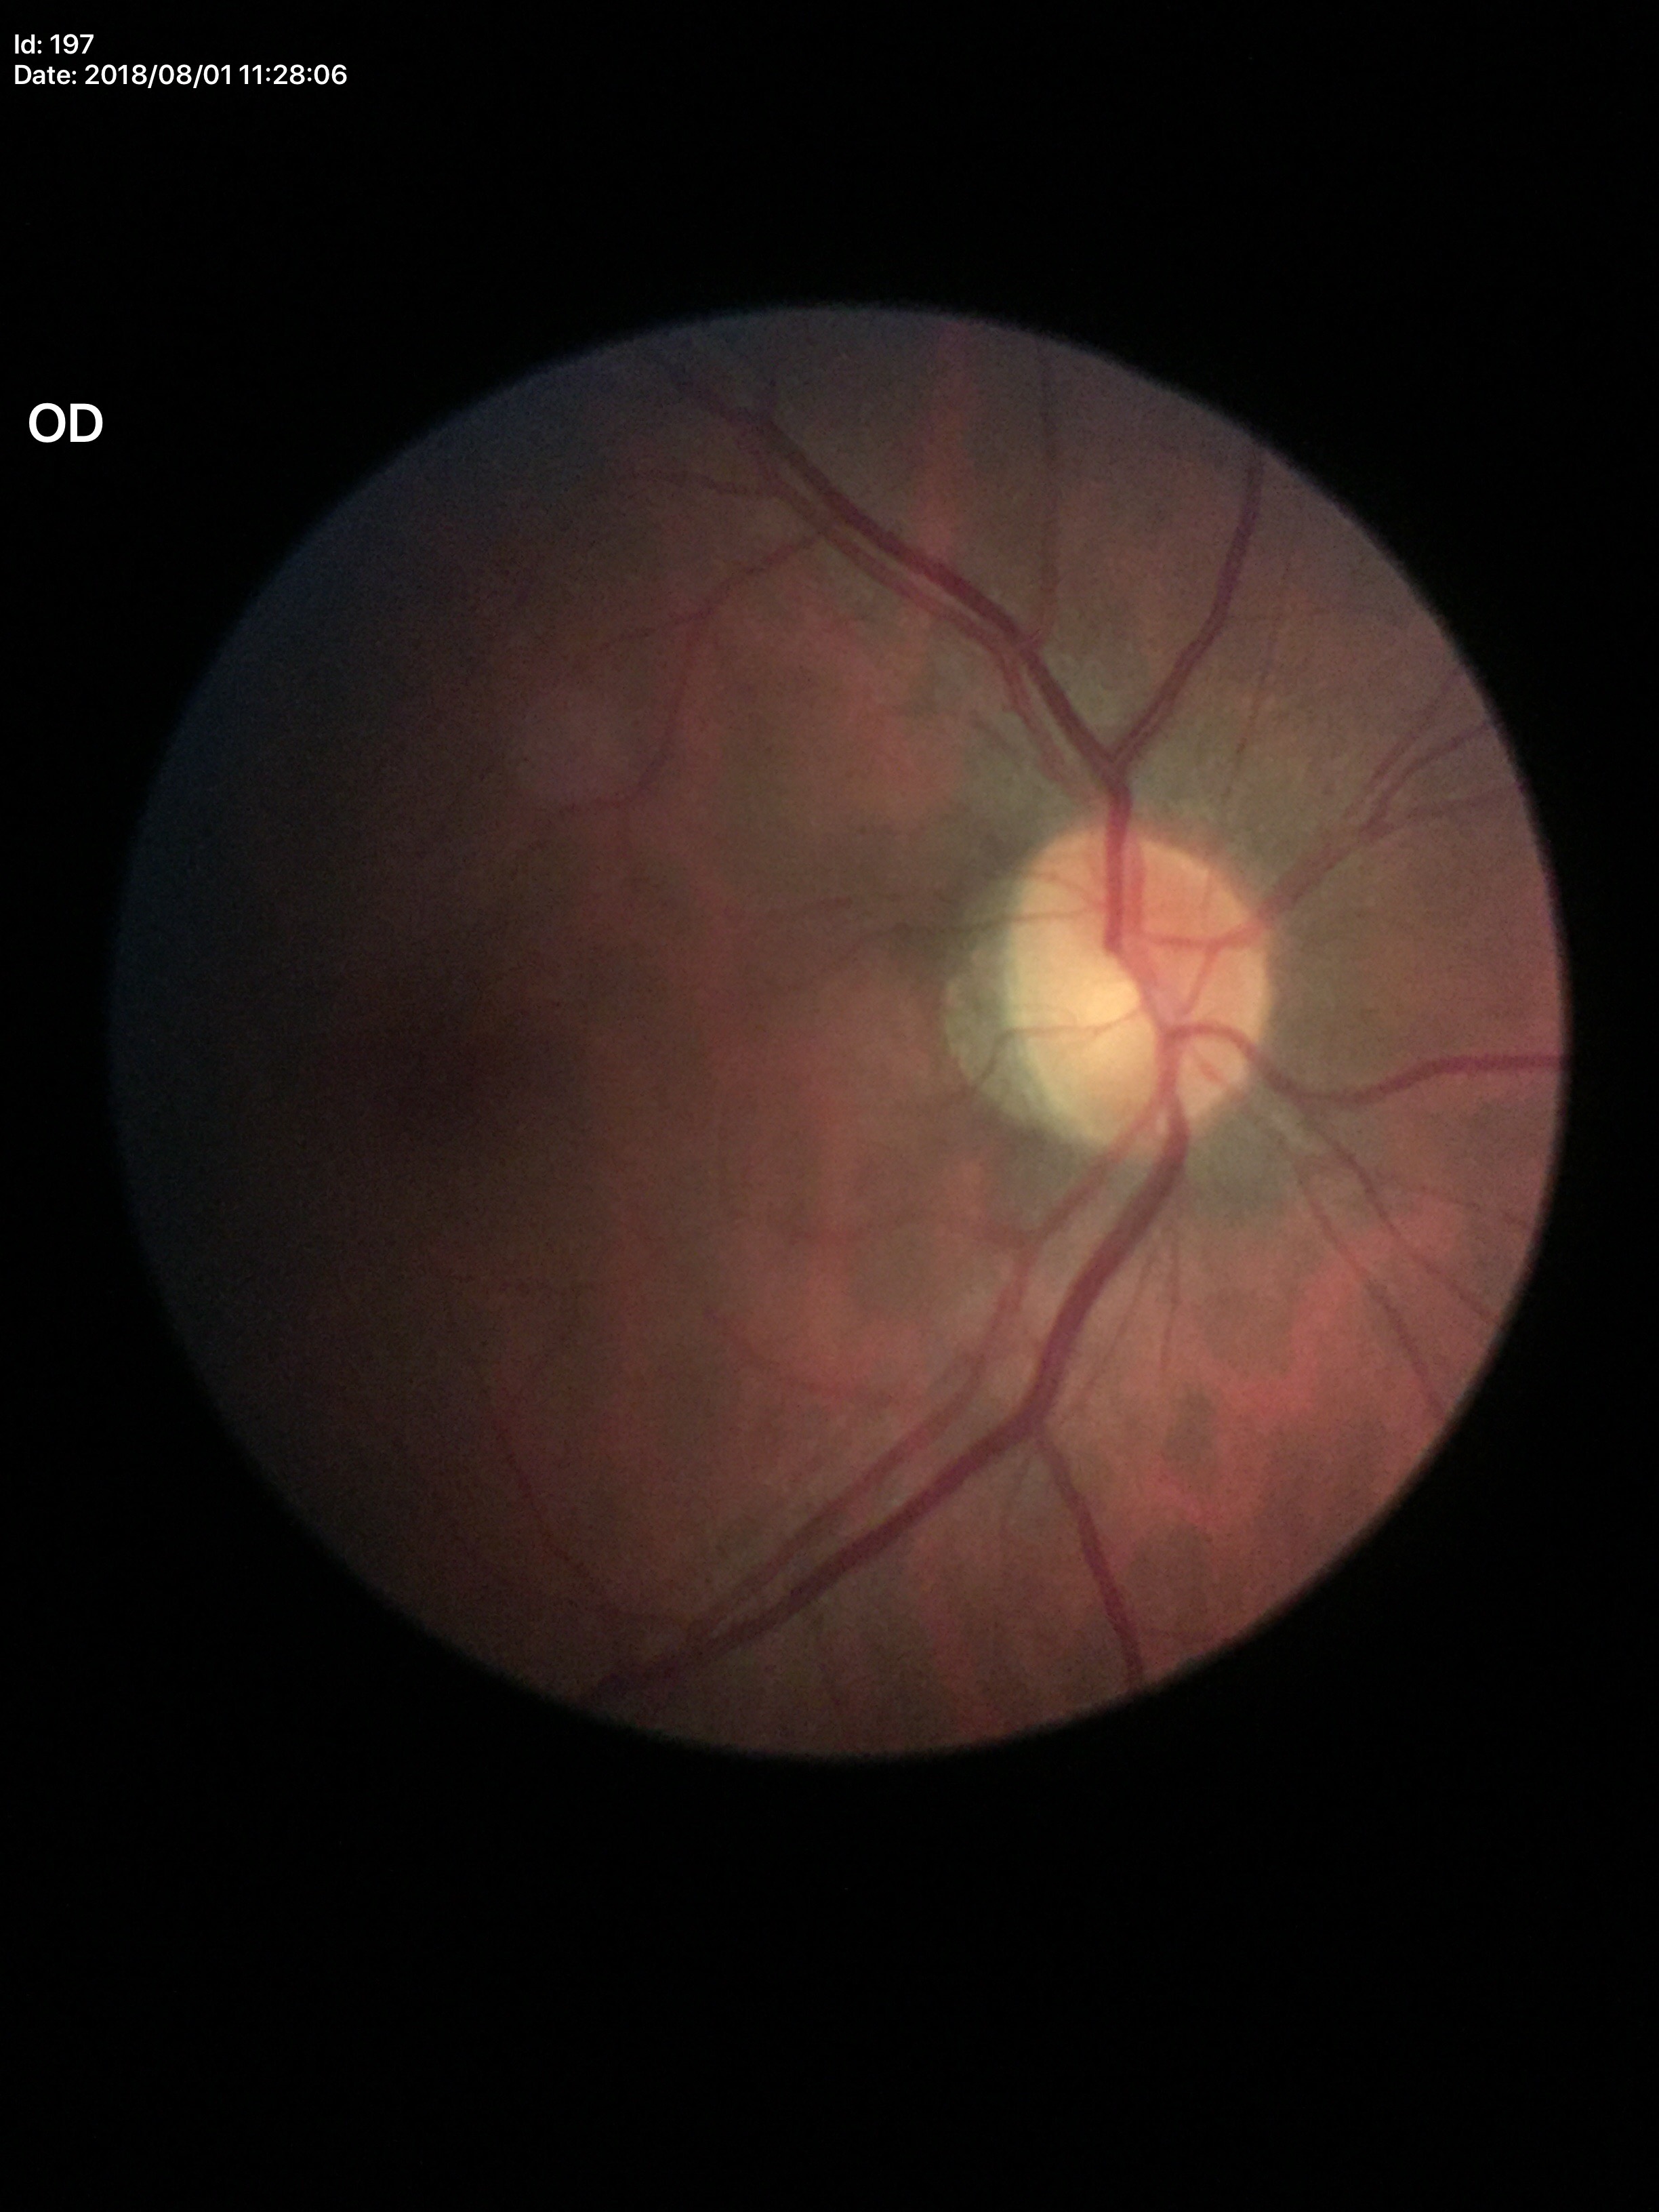

Q: What is the glaucoma assessment?
A: not suspect (unanimous normal call)
Q: What is the VCDR?
A: 0.45